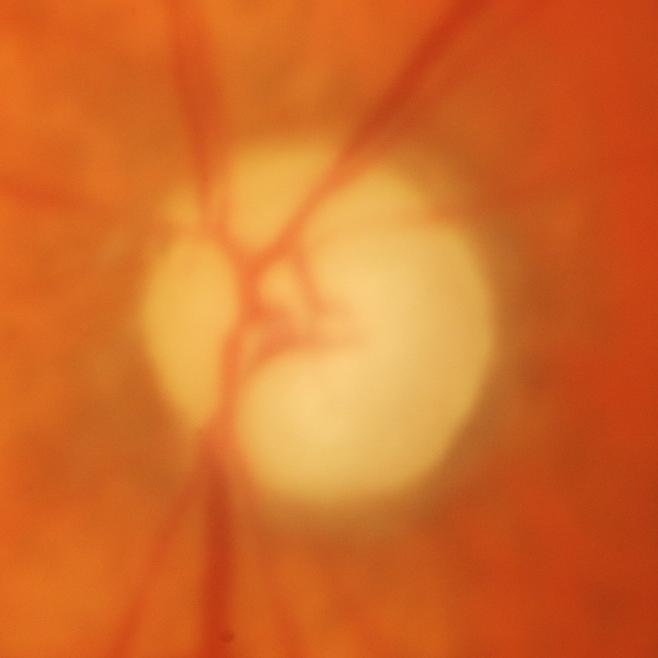
Glaucomatous optic neuropathy.